Graded on the modified Davis scale:
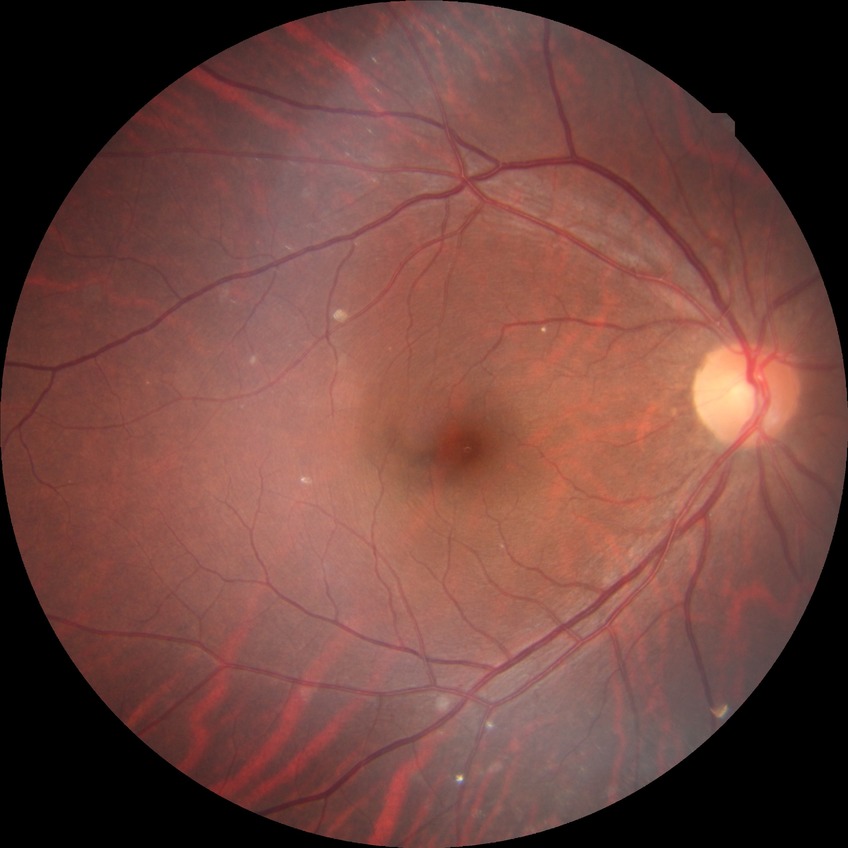 Diabetic retinopathy severity is no diabetic retinopathy.